FOV: 45 degrees — 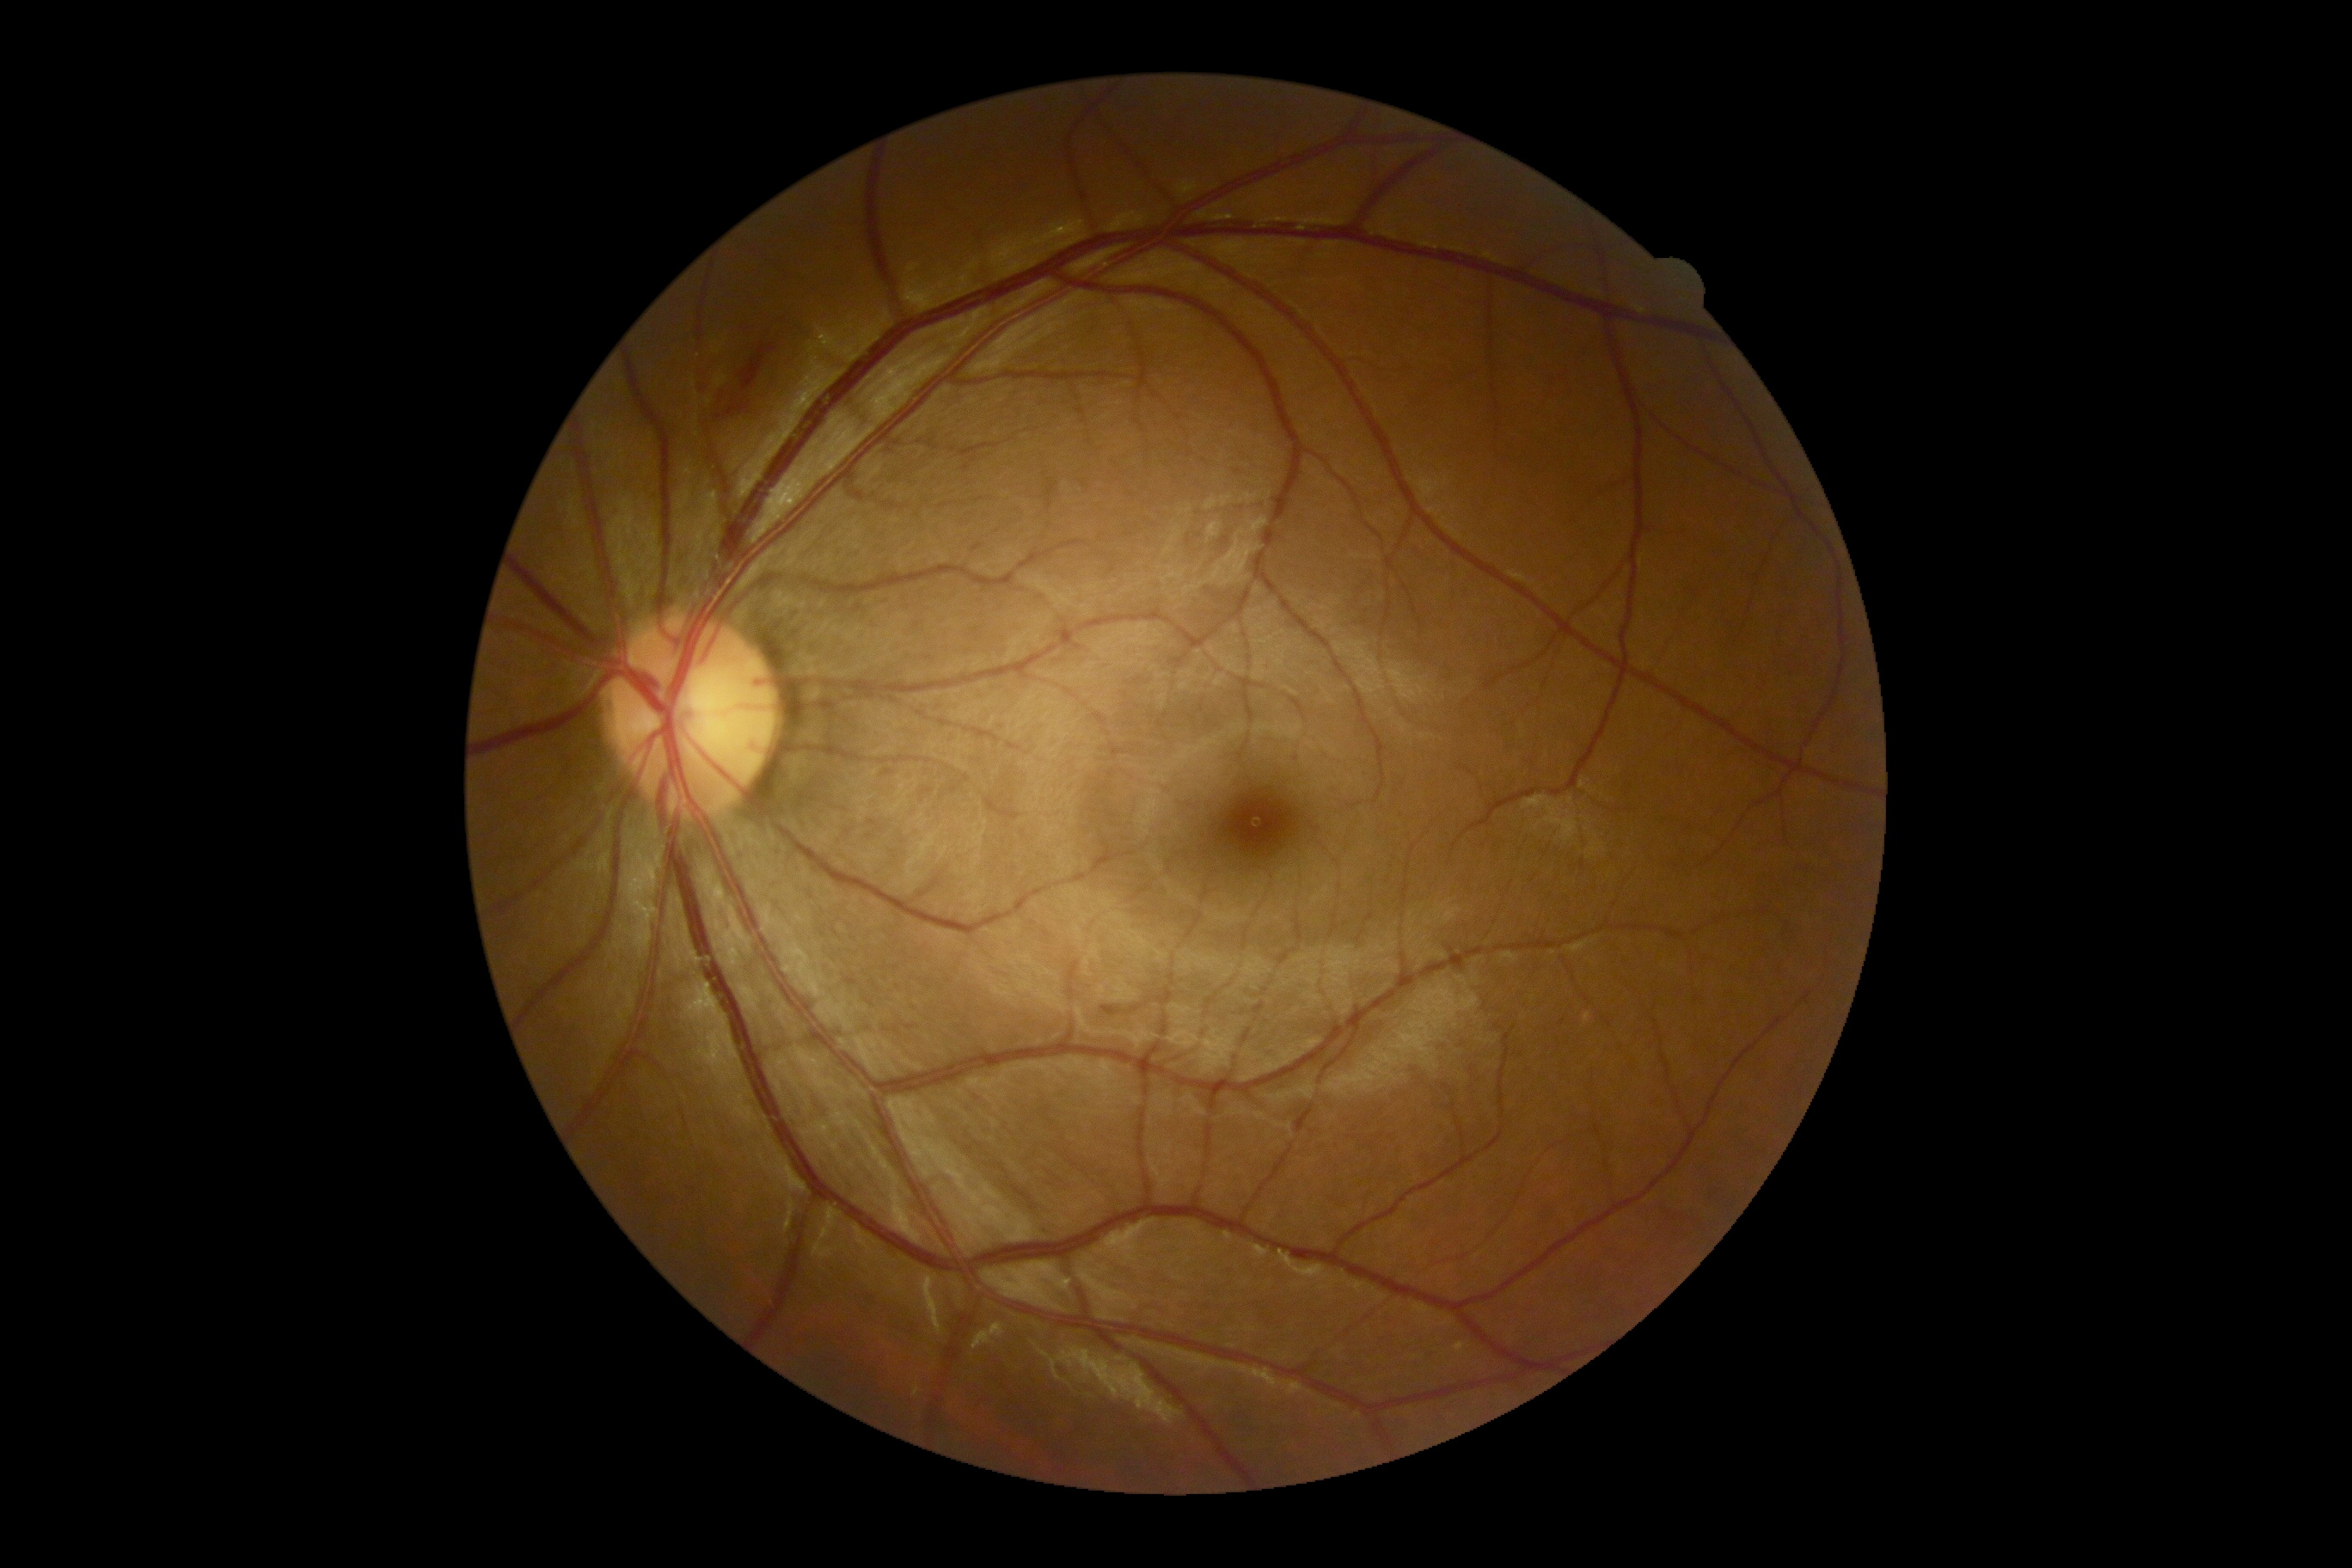 Diabetic retinopathy grade: 2.